Image size 848x848
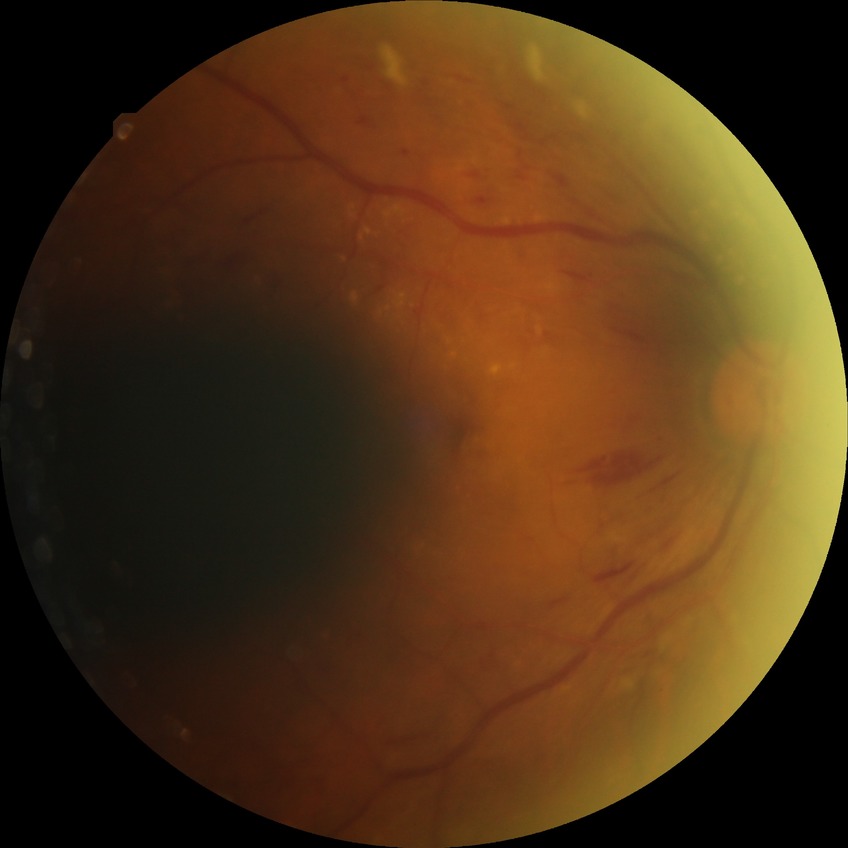

Diabetic retinopathy (DR) is pre-proliferative diabetic retinopathy (PPDR).